Captured with the Clarity RetCam 3 (130° field of view) · RetCam wide-field infant fundus image:
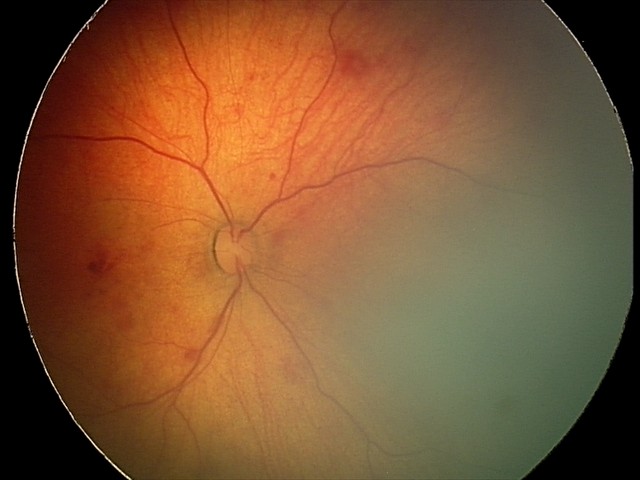
Impression = retinal hemorrhages.